Wide-field fundus photograph of an infant.
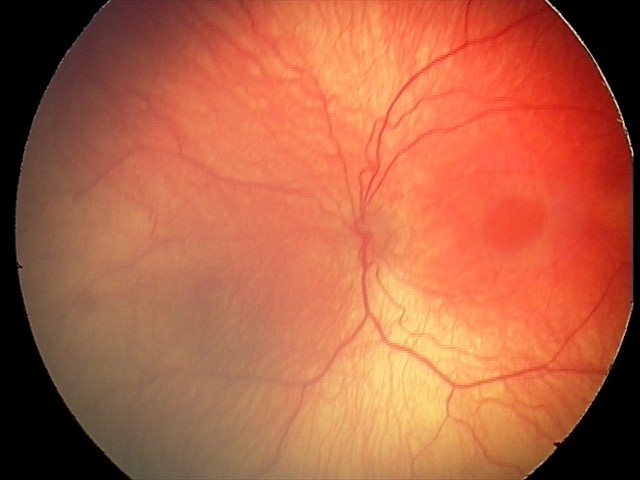
No plus disease.
Screening examination consistent with retinopathy of prematurity (ROP) stage 2.